Color fundus image
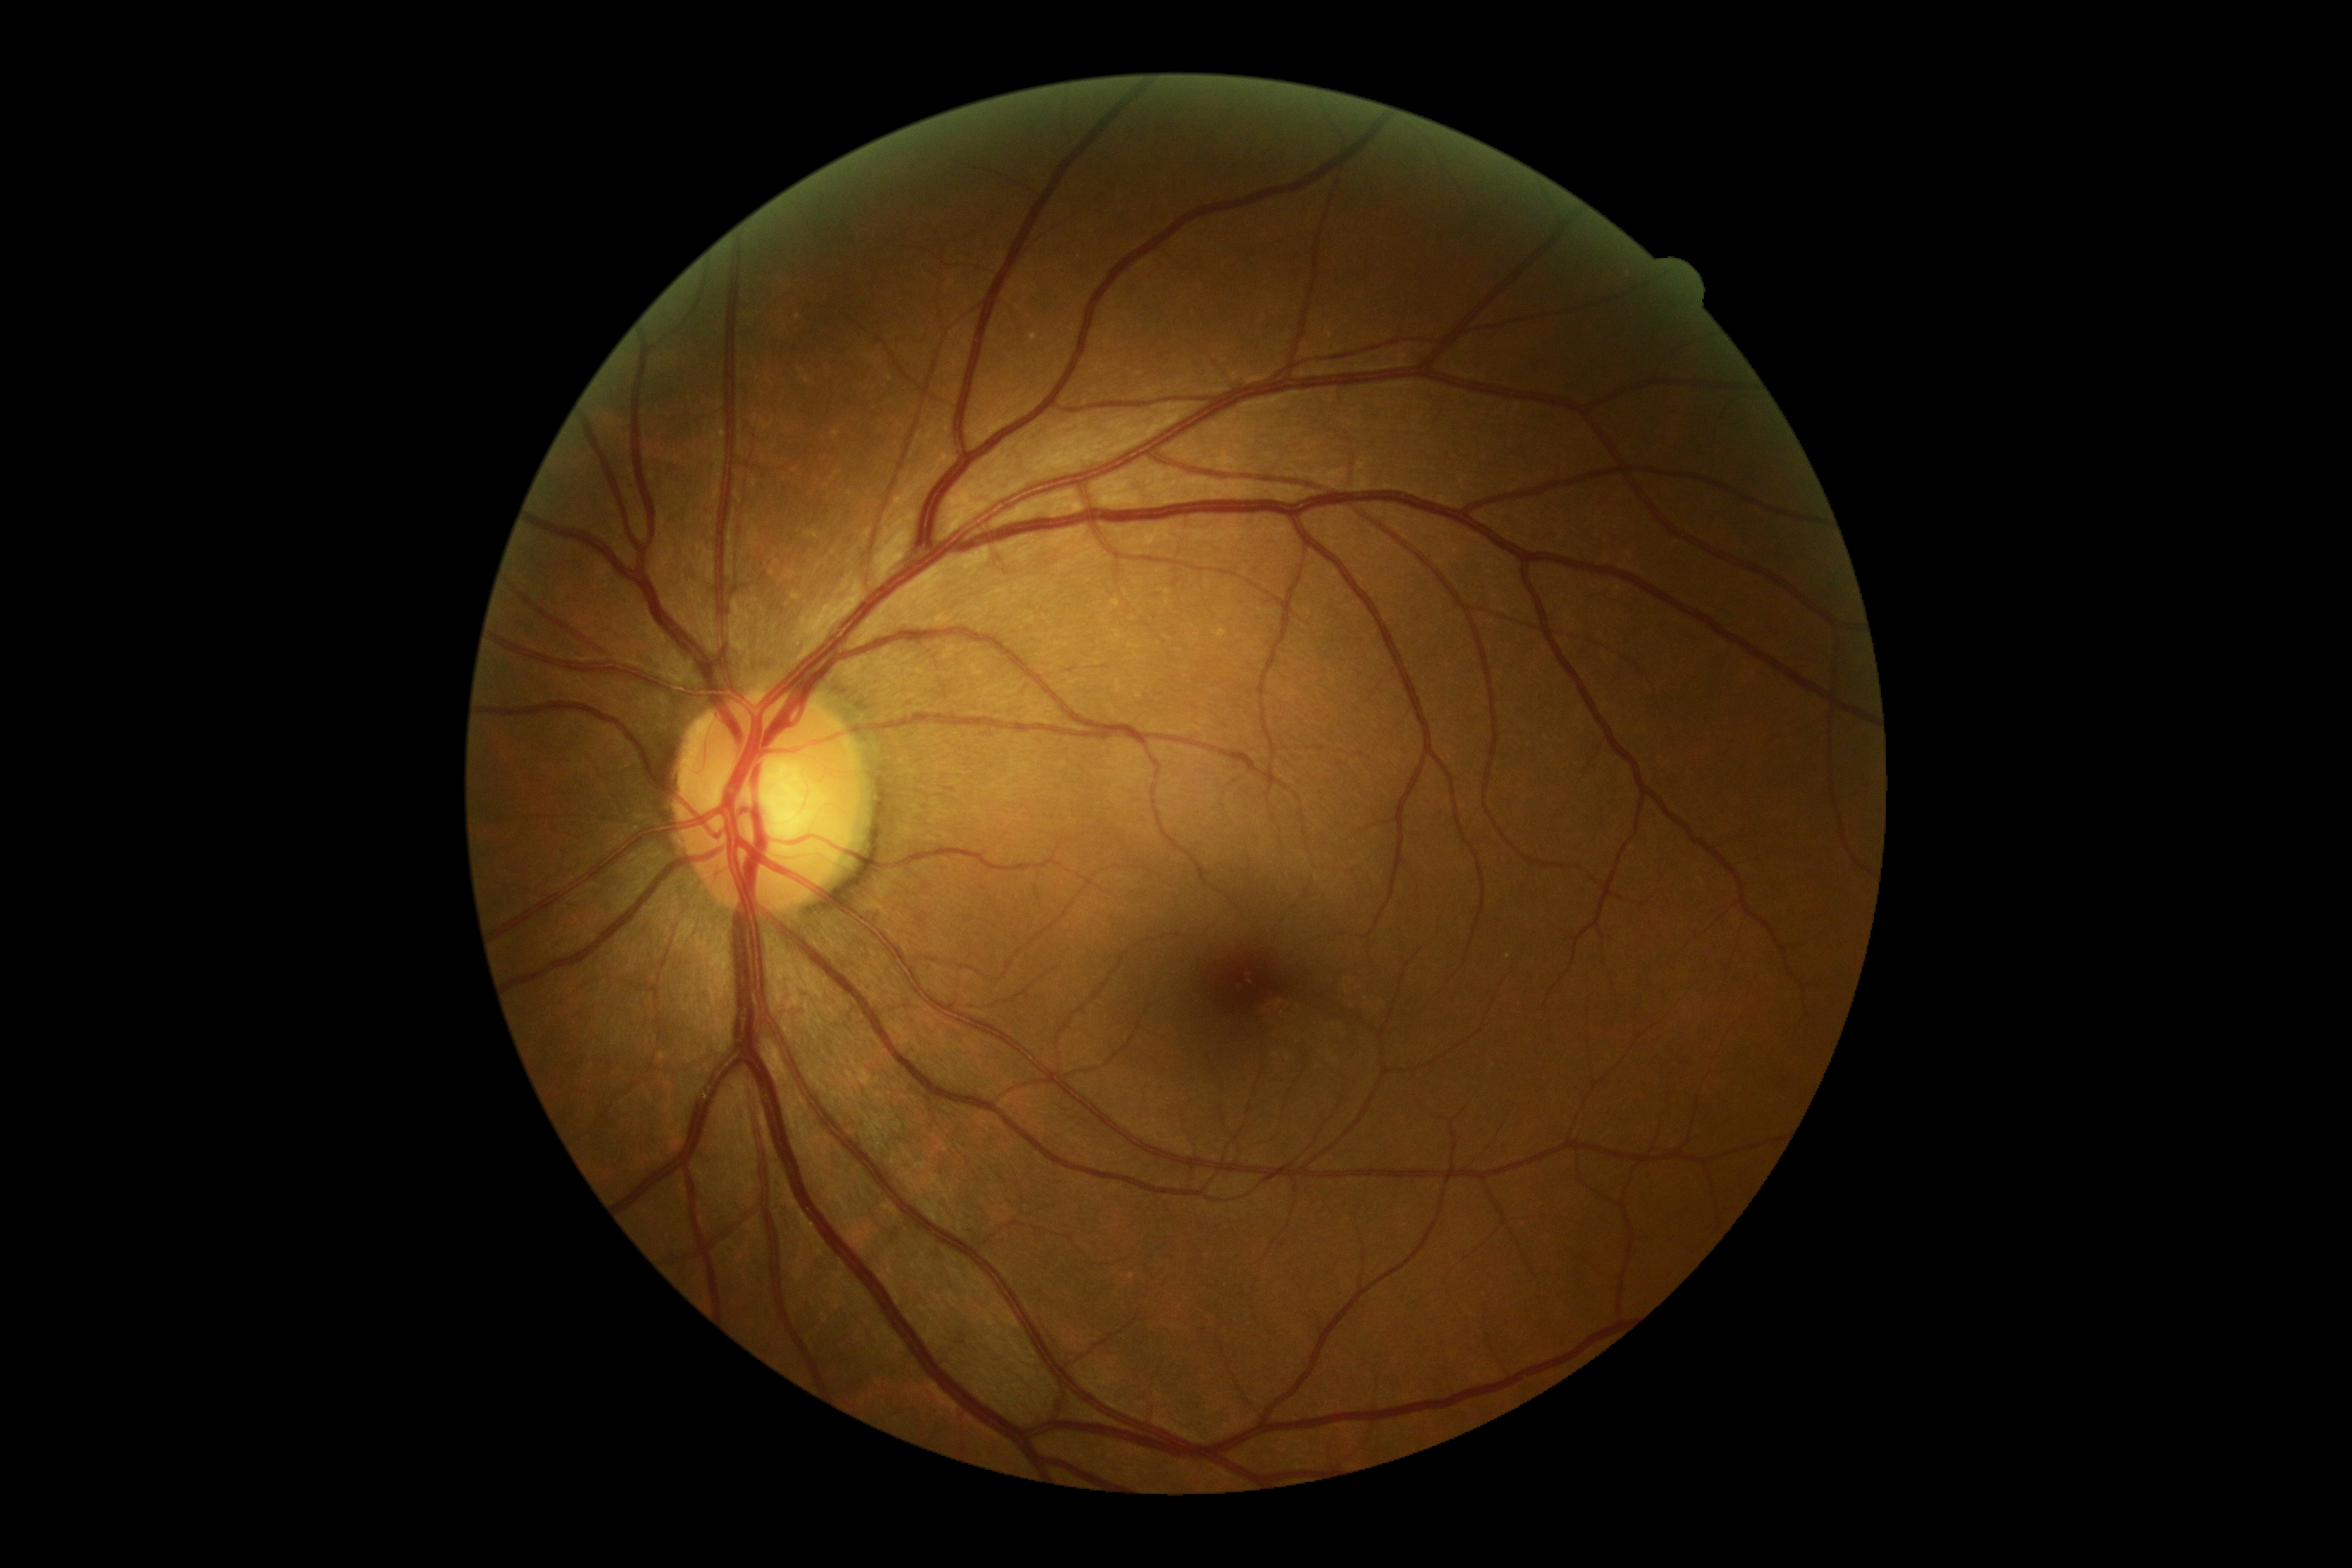

DR severity is grade 0 (no apparent retinopathy).